Nonmydriatic fundus photograph, posterior pole color fundus photograph, Davis DR grading, 45° field of view:
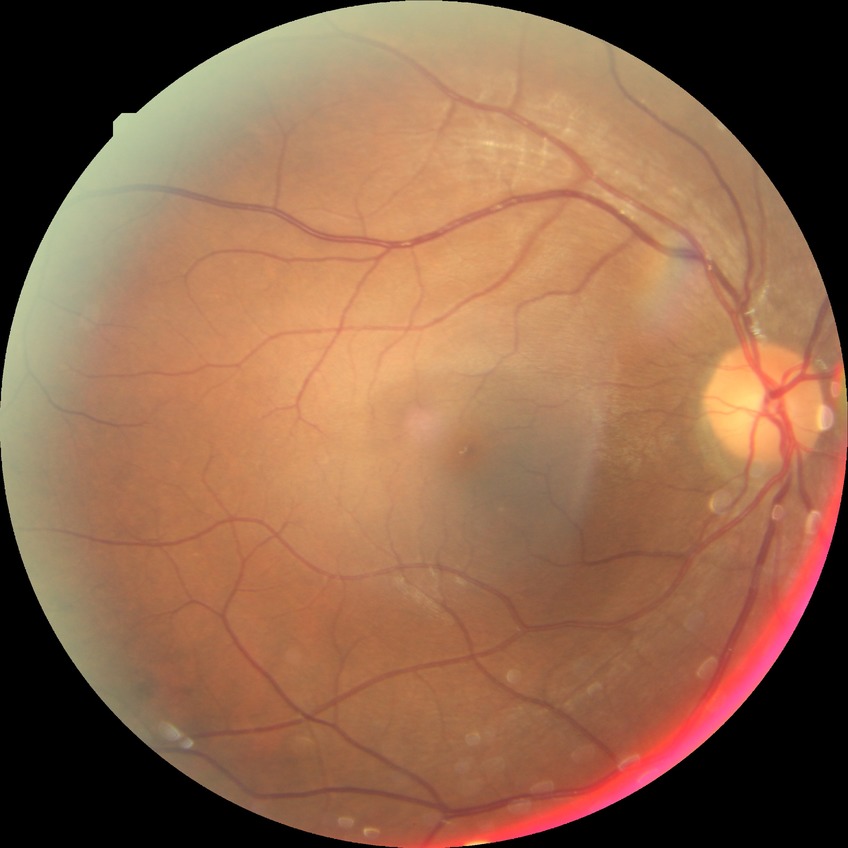 Diabetic retinopathy (DR): NDR (no diabetic retinopathy).